2352x1568.
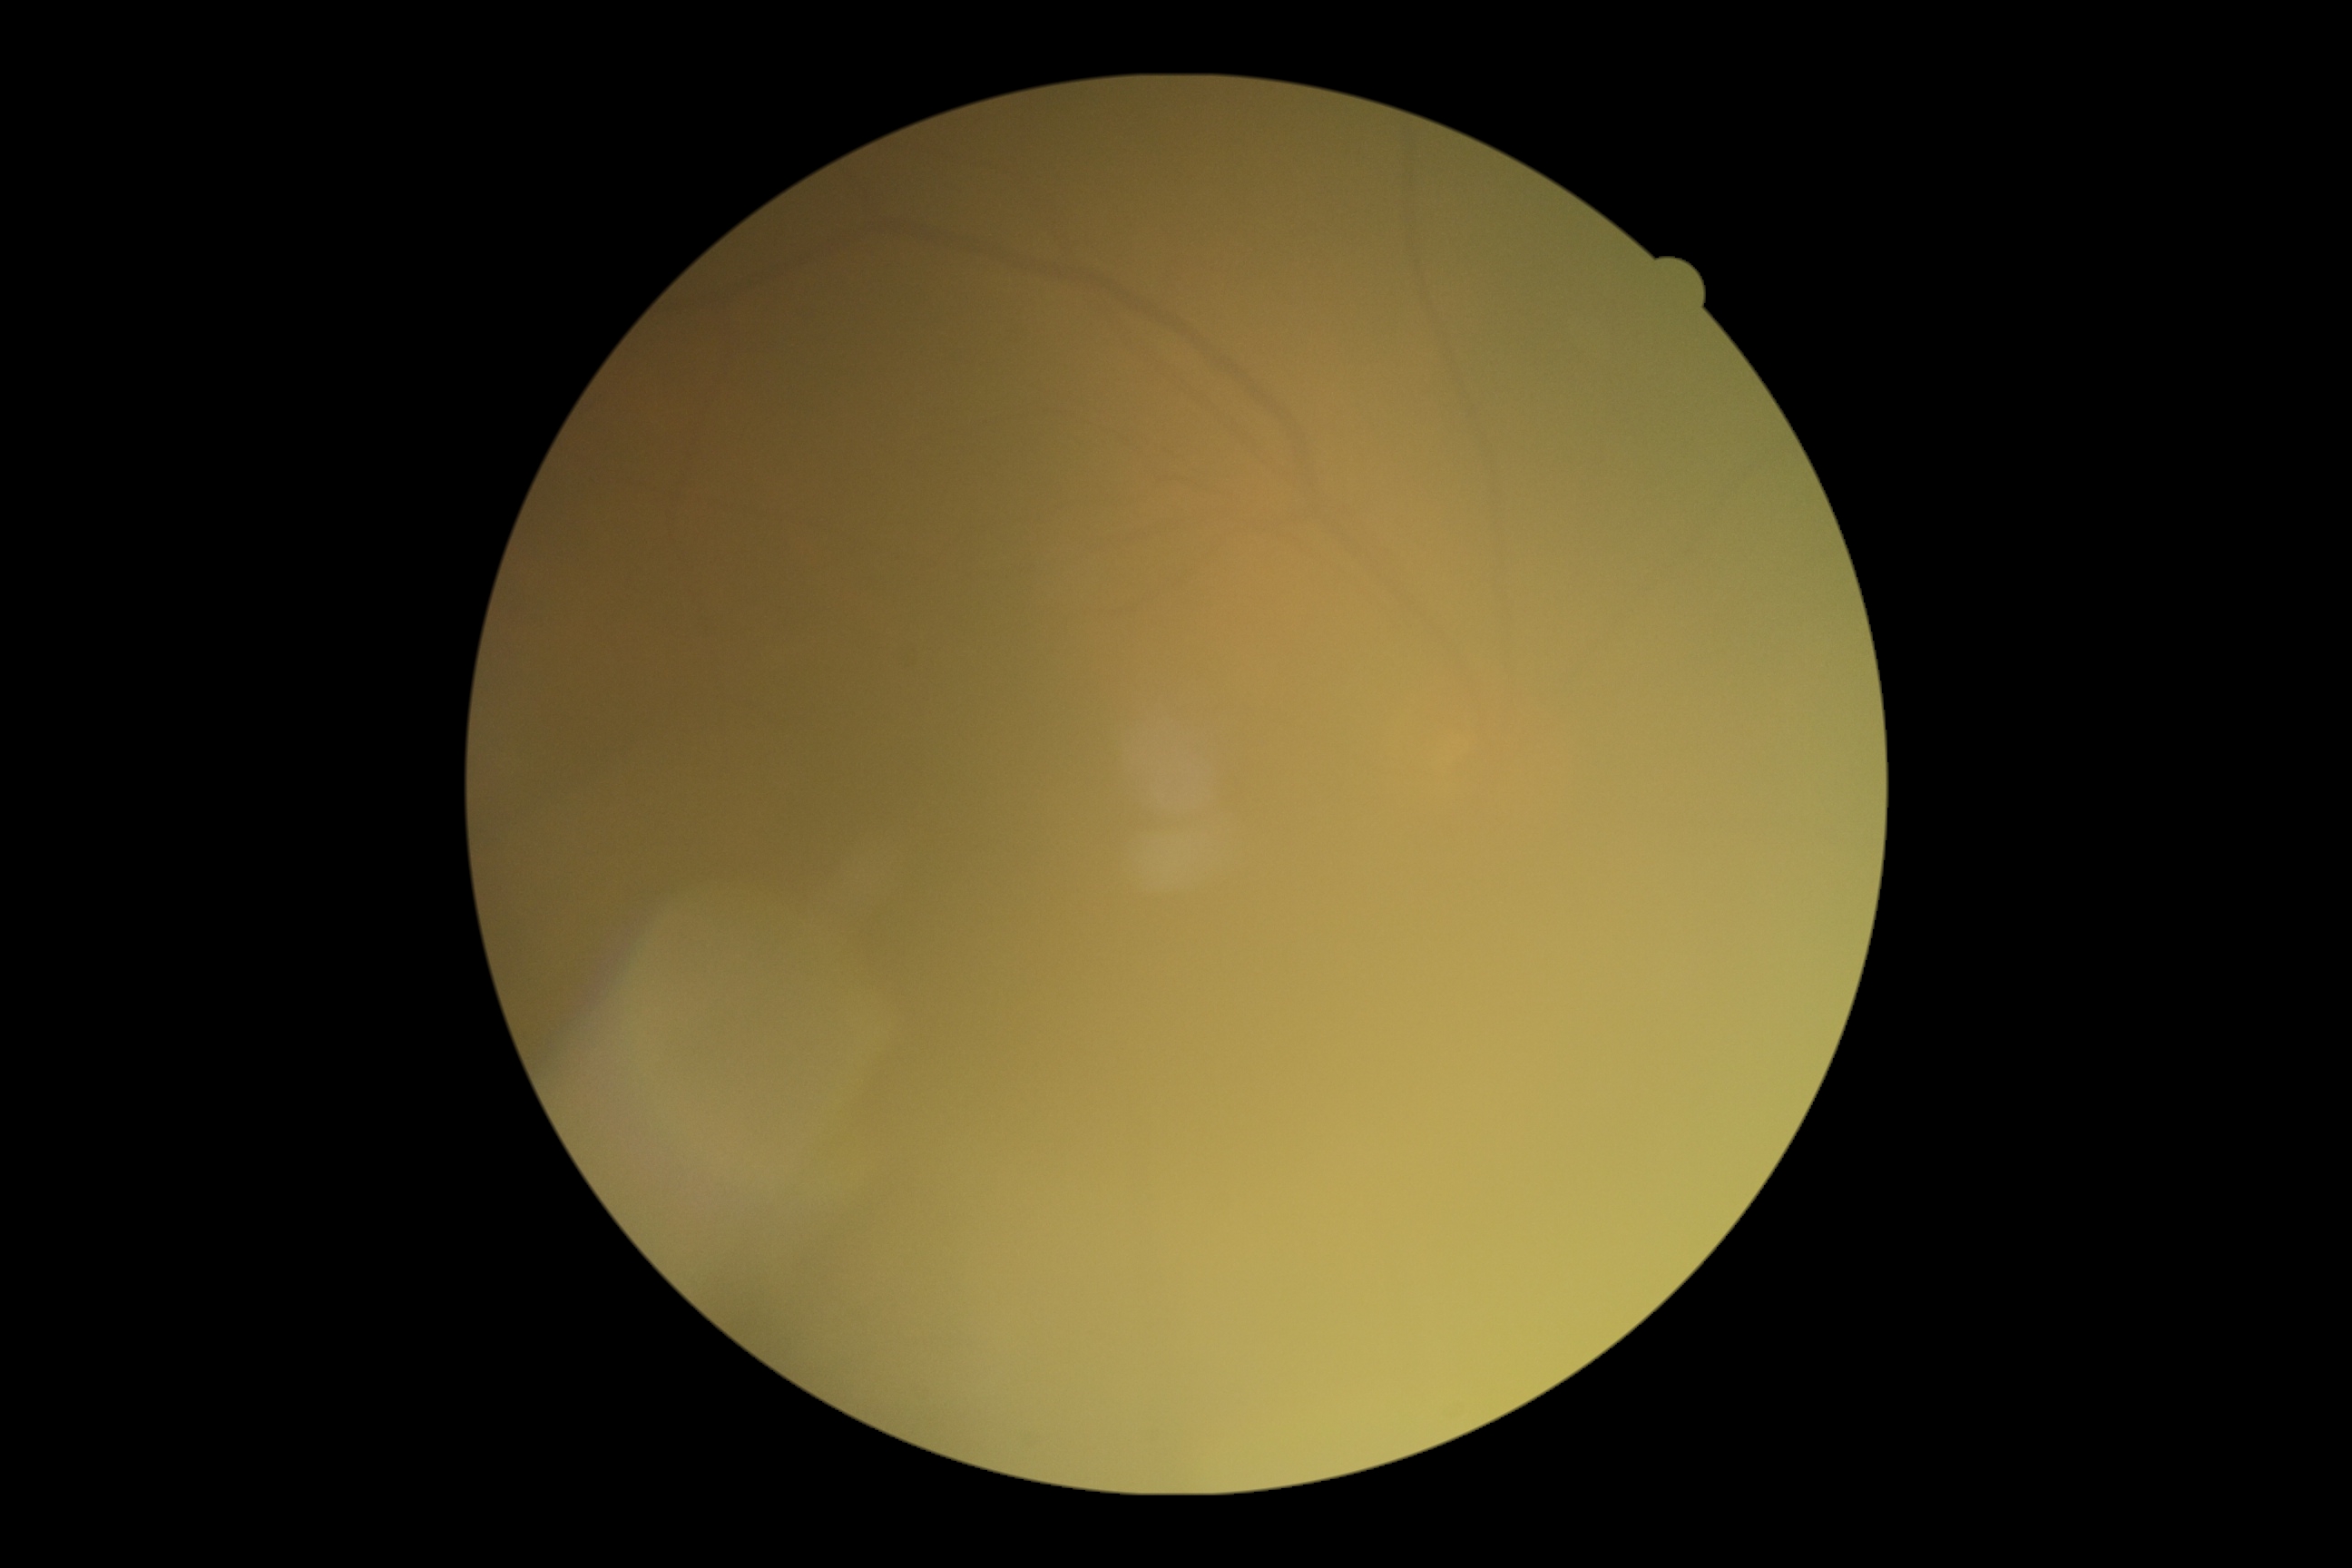

Quality too poor to assess for DR. Diabetic retinopathy (DR): ungradable due to poor image quality.